1240x1240px; wide-field fundus photograph of an infant.
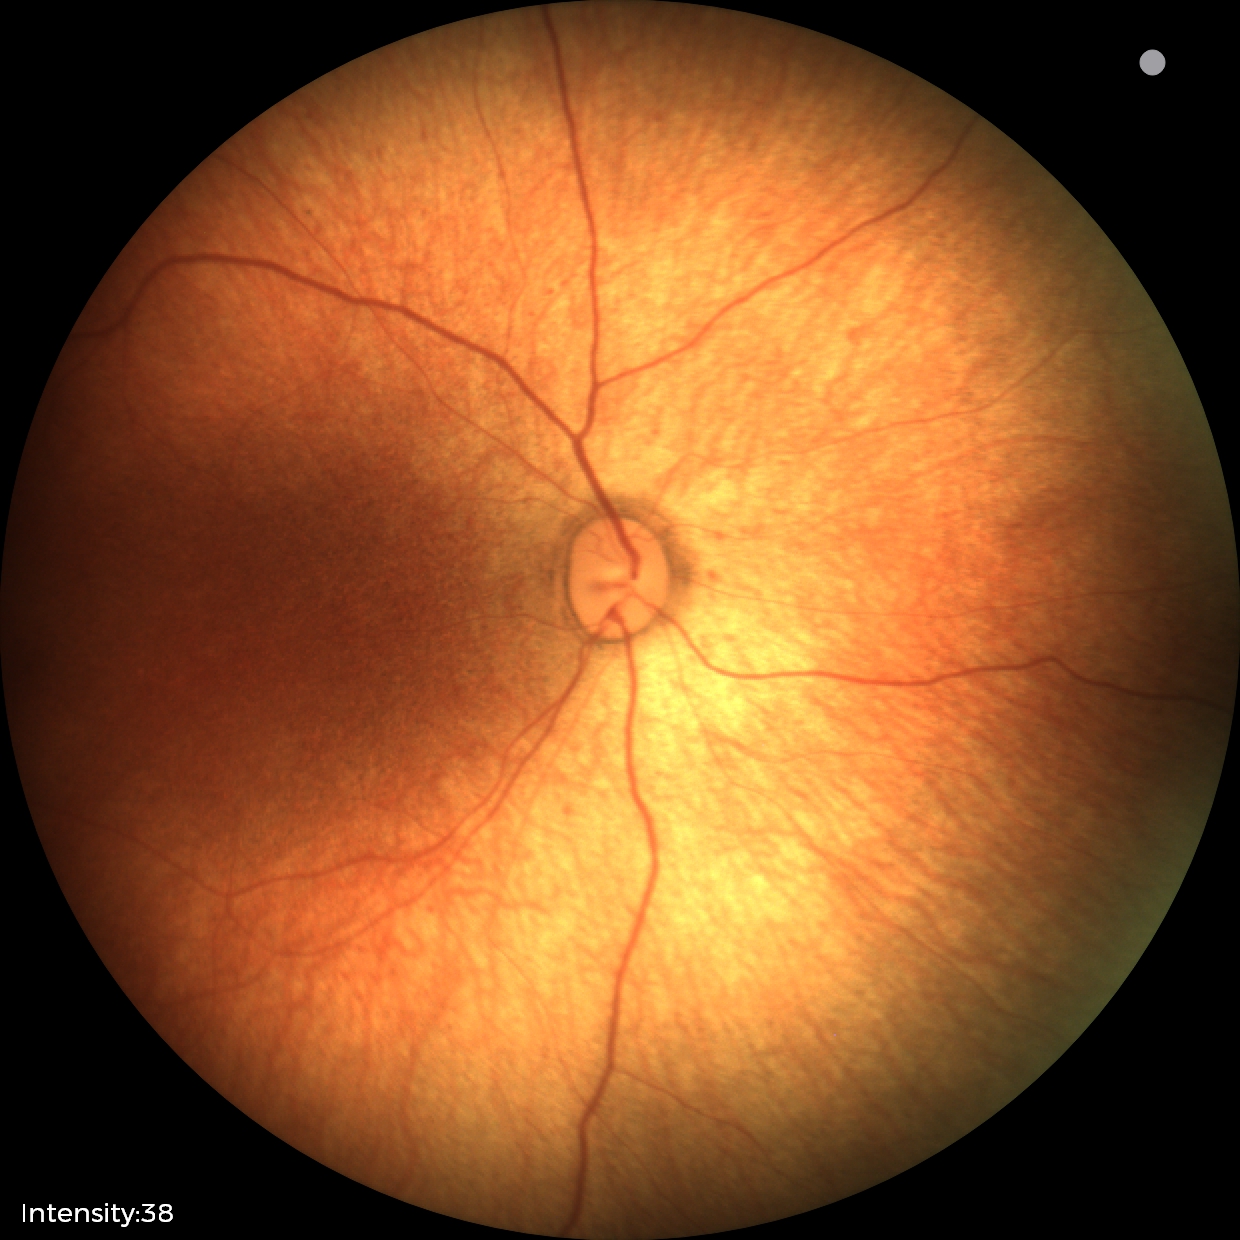
Screening examination diagnosed as physiological.